Camera: Phoenix ICON (100° FOV) · wide-field contact fundus photograph of an infant.
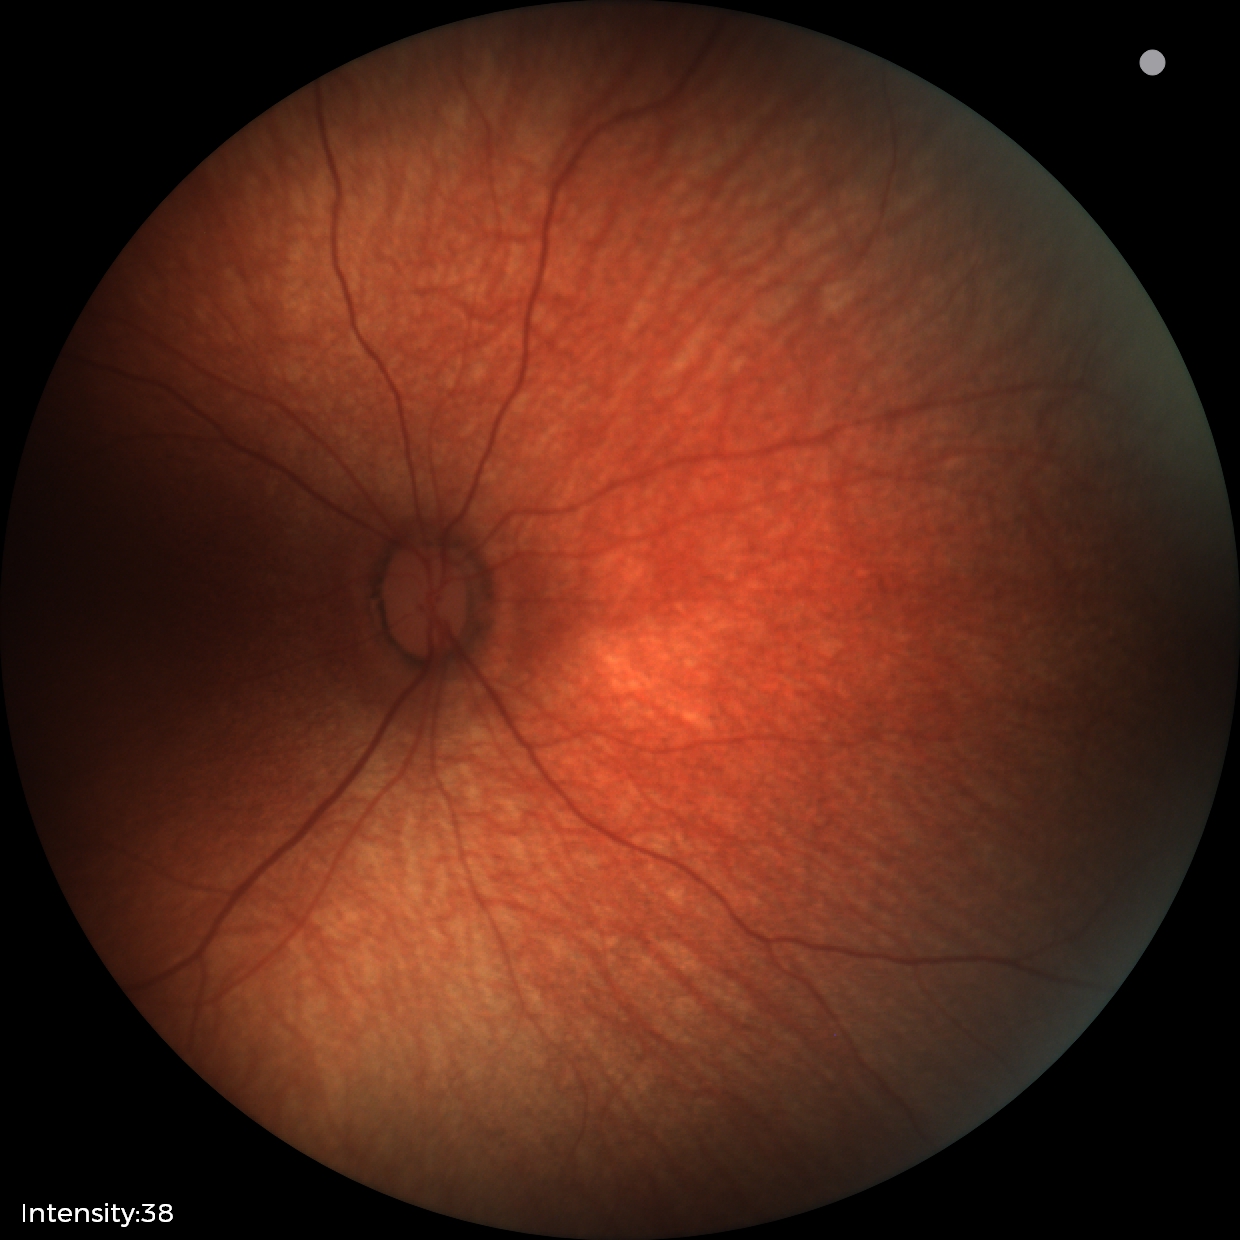
Examination with physiological retinal findings.